Nonmydriatic fundus photograph. 848 by 848 pixels. Camera: NIDEK AFC-230. Retinal fundus photograph.
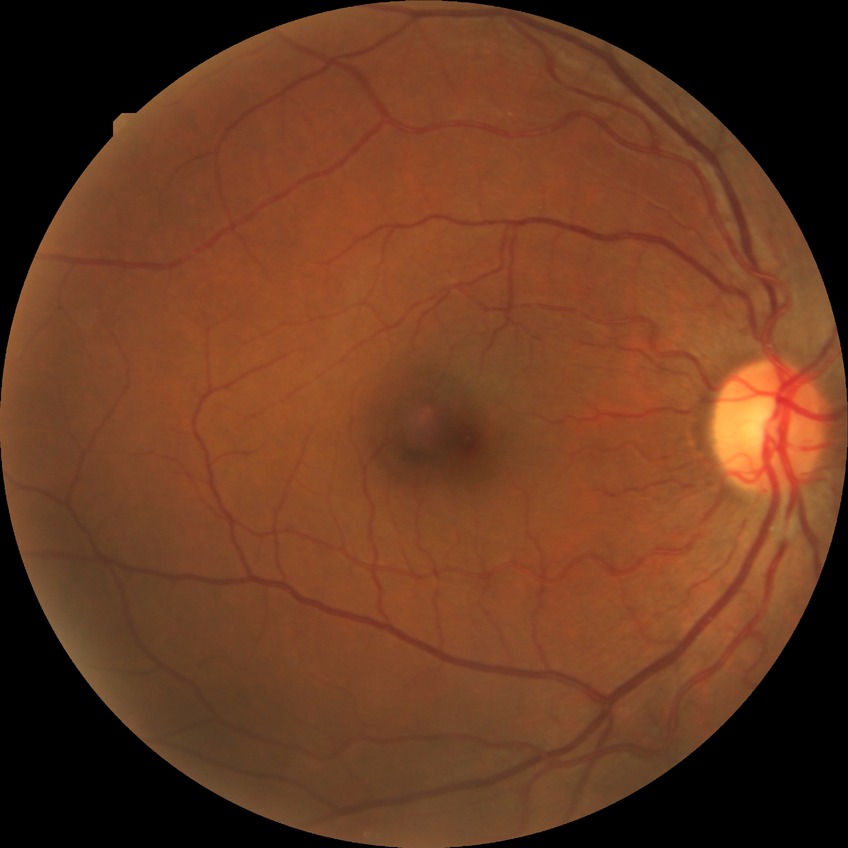 diabetic retinopathy (DR)=no diabetic retinopathy (NDR).